45° field of view; camera: NIDEK AFC-230; posterior pole color fundus photograph; without pupil dilation — 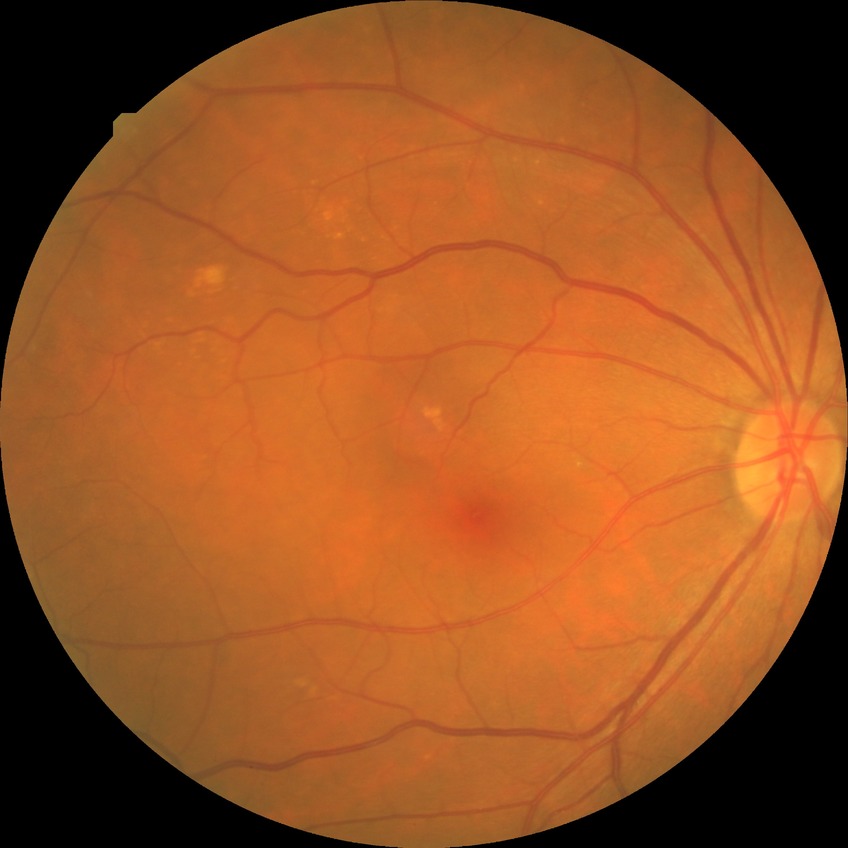
modified Davis grading = no diabetic retinopathy.